Wide-field fundus image from infant ROP screening
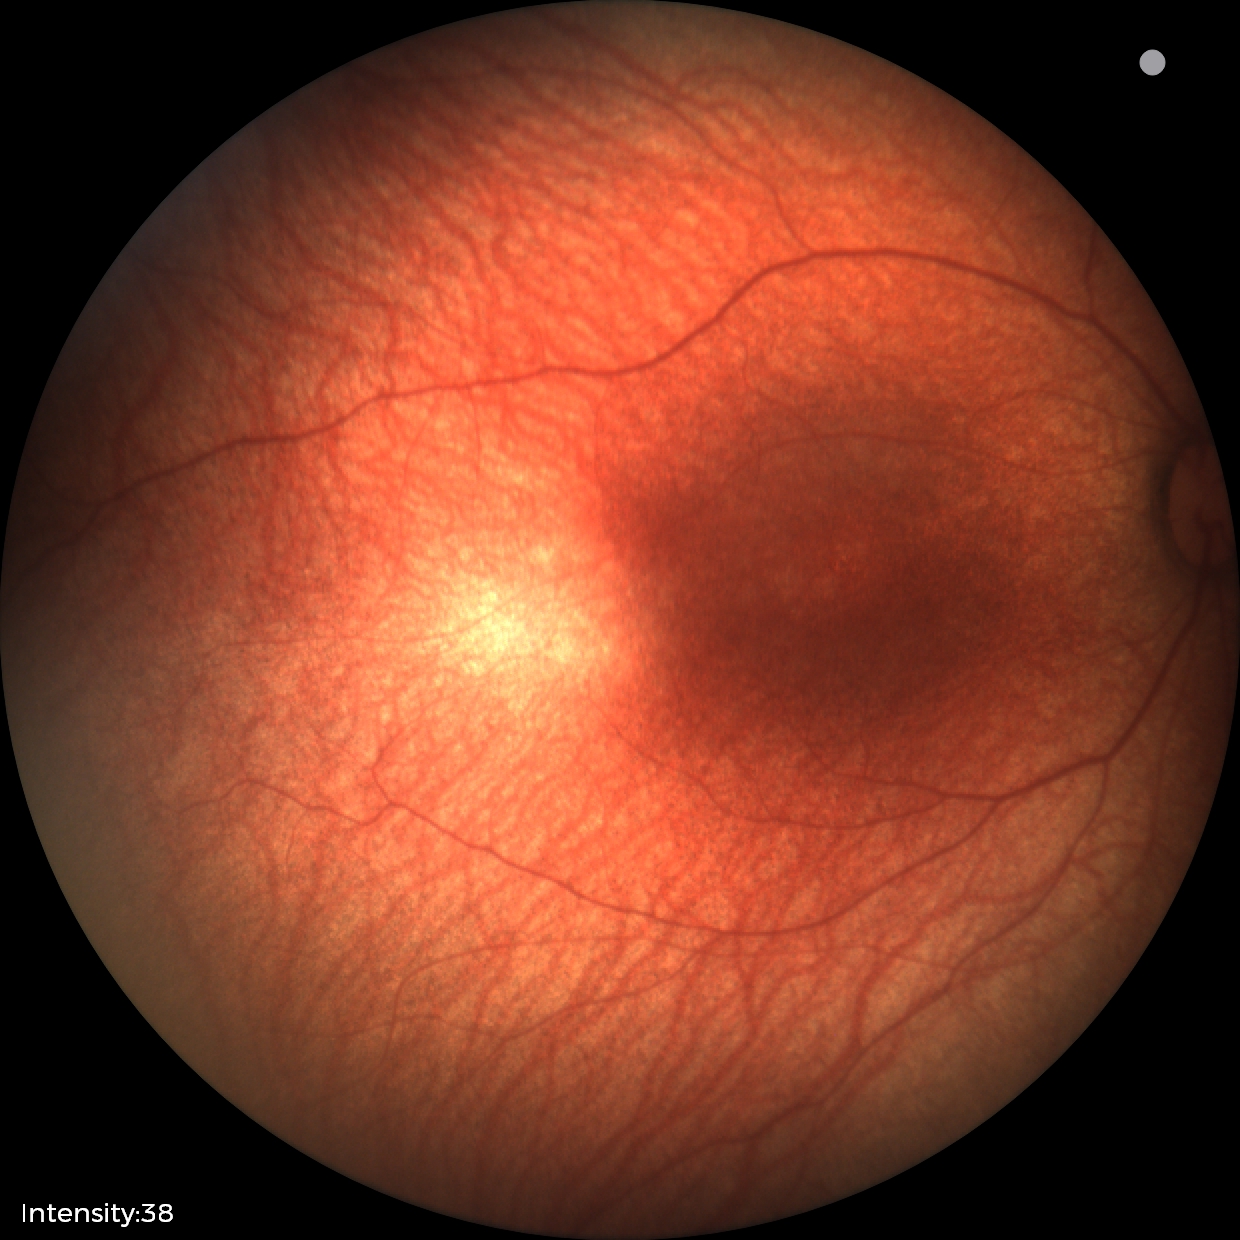
Q: What is the diagnosis from this examination?
A: normal retinal appearance